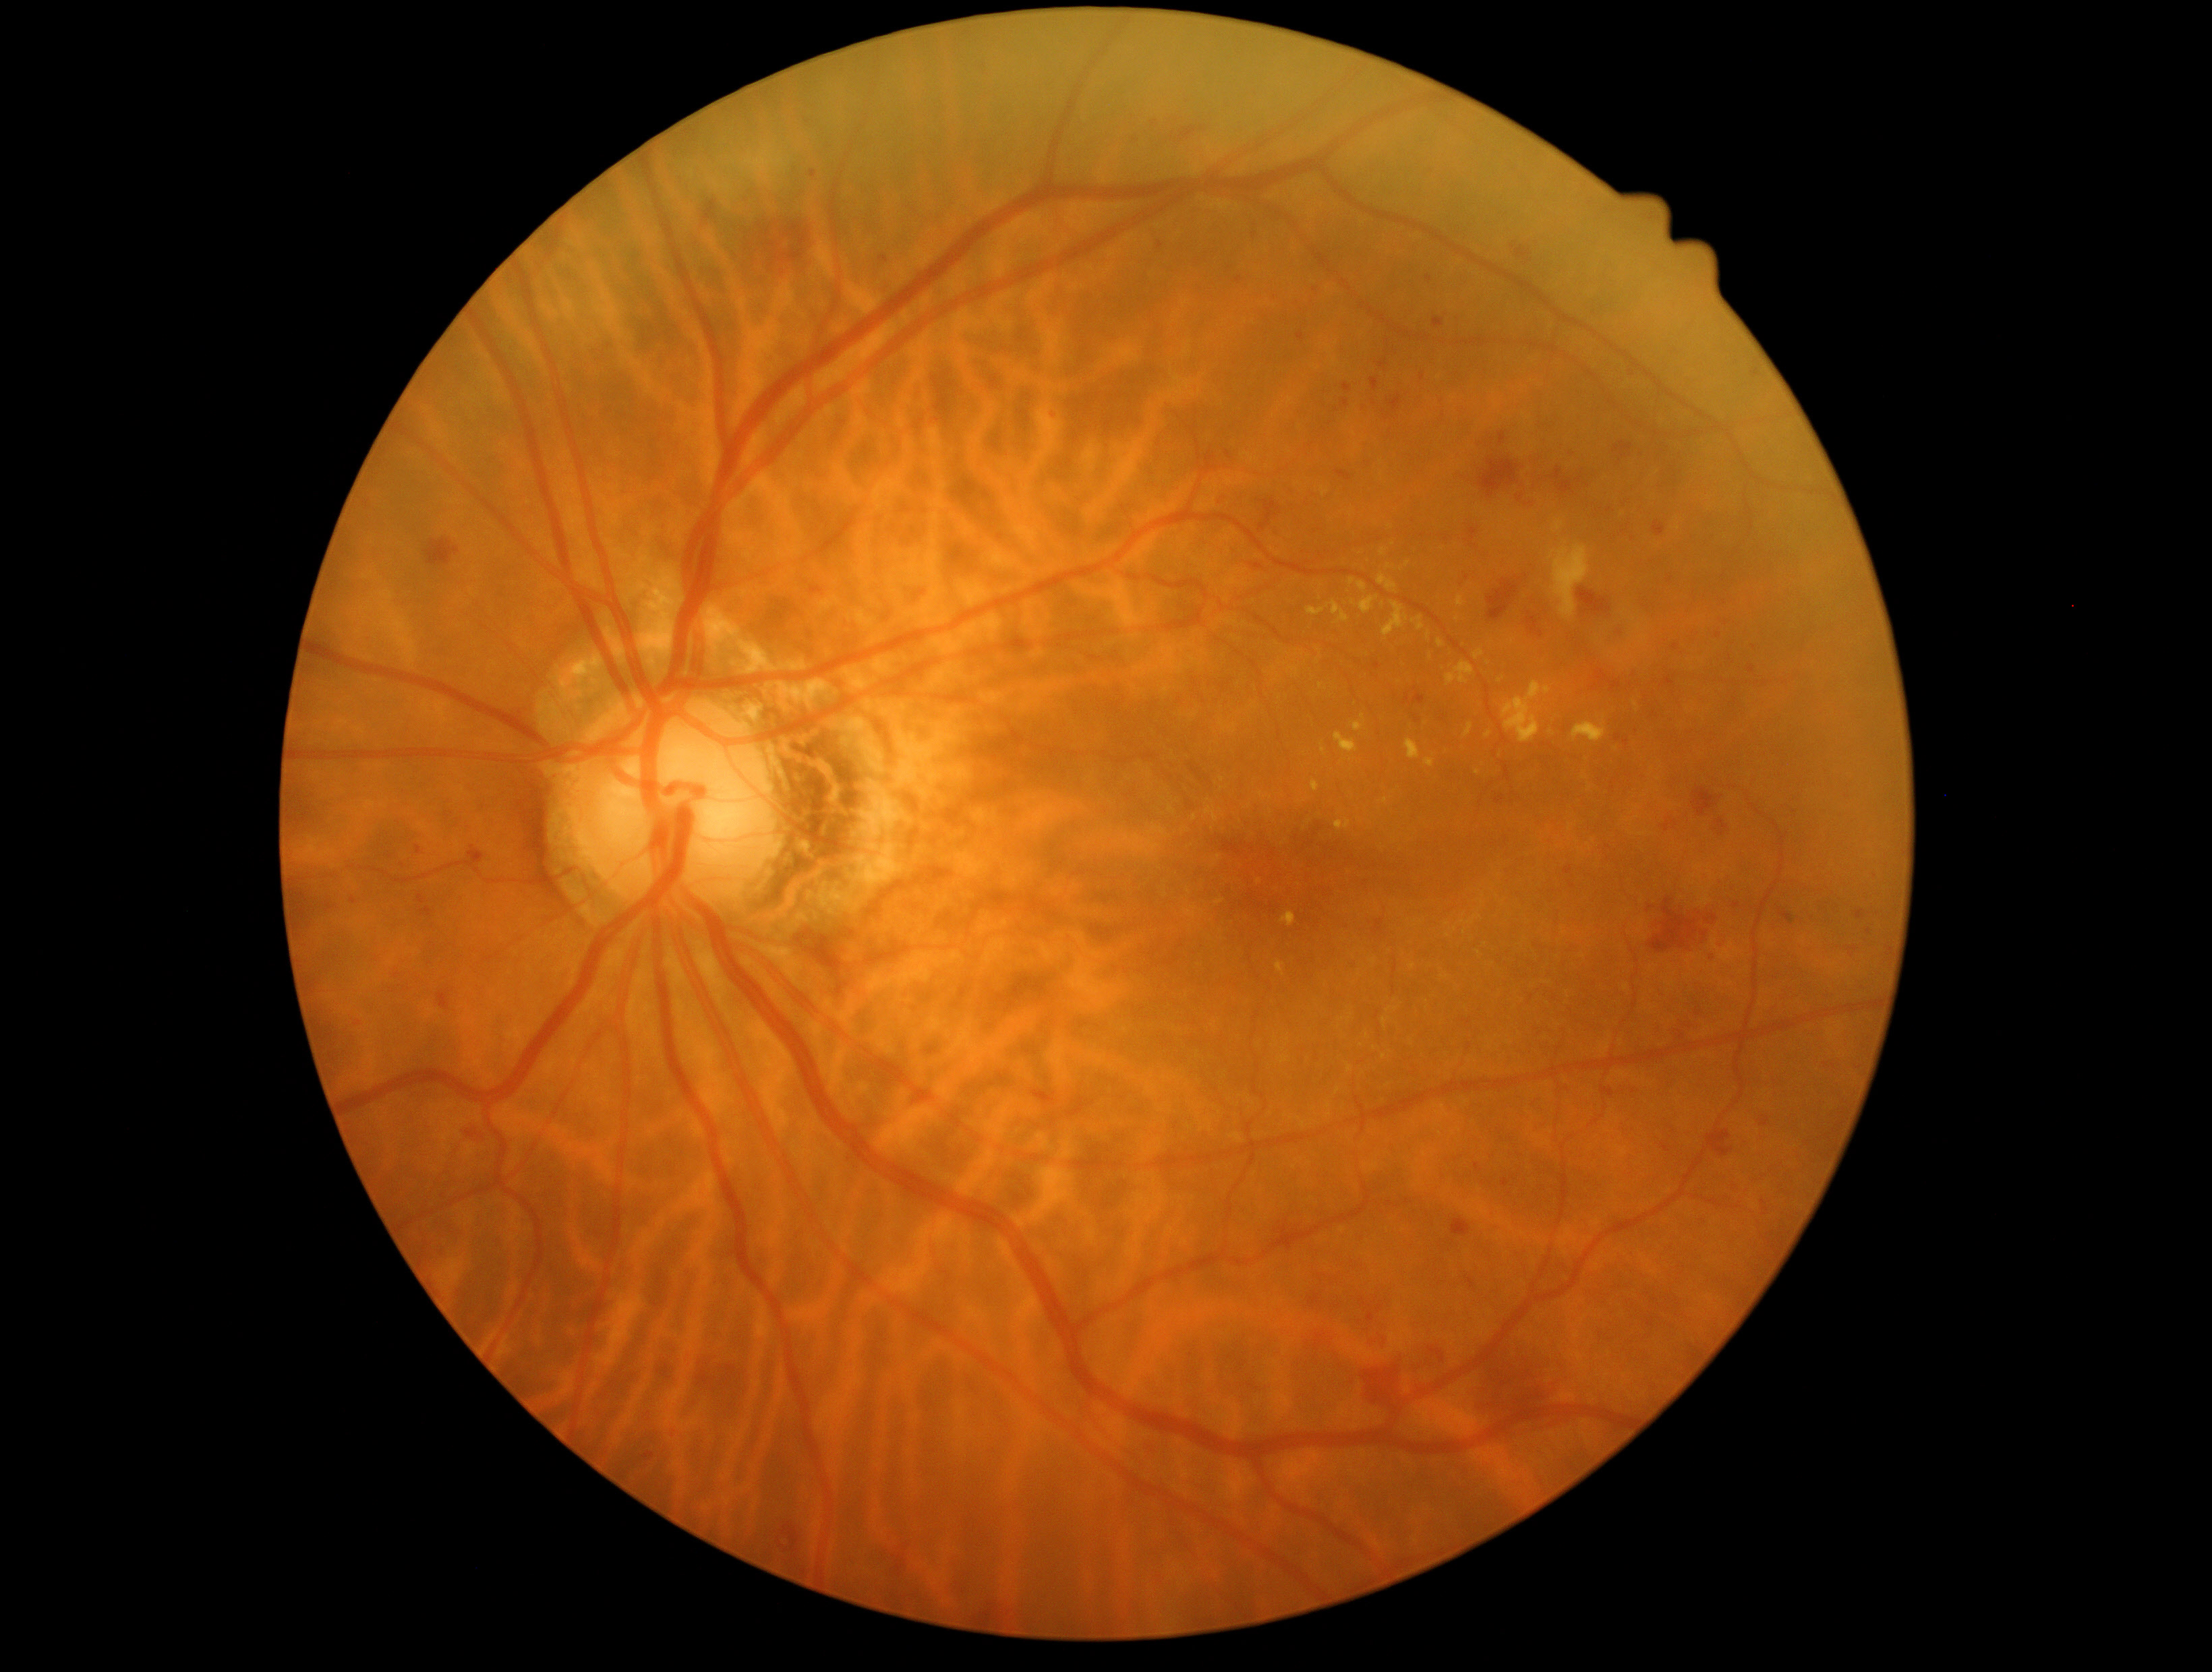
partial: true
dr_grade: 2
dr_grade_name: moderate NPDR
lesions:
  he:
    - [x1=1457, y1=568, x2=1483, y2=591]
    - [x1=1314, y1=1334, x2=1325, y2=1352]
    - [x1=417, y1=895, x2=427, y2=904]
    - [x1=1213, y1=491, x2=1229, y2=506]
    - [x1=1351, y1=1228, x2=1368, y2=1244]
    - [x1=1475, y1=1163, x2=1480, y2=1172]
    - [x1=1692, y1=788, x2=1724, y2=816]
    - [x1=1873, y1=873, x2=1881, y2=881]
    - [x1=1363, y1=1340, x2=1449, y2=1415]
    - [x1=993, y1=531, x2=1007, y2=543]
    - [x1=643, y1=1453, x2=656, y2=1461]
    - [x1=1414, y1=715, x2=1420, y2=723]
    - [x1=1666, y1=714, x2=1675, y2=723]
    - [x1=1363, y1=1333, x2=1391, y2=1349]
    - [x1=1683, y1=626, x2=1701, y2=645]
  he_small_centers:
    - 1735:701
    - 1254:236
    - 1513:247